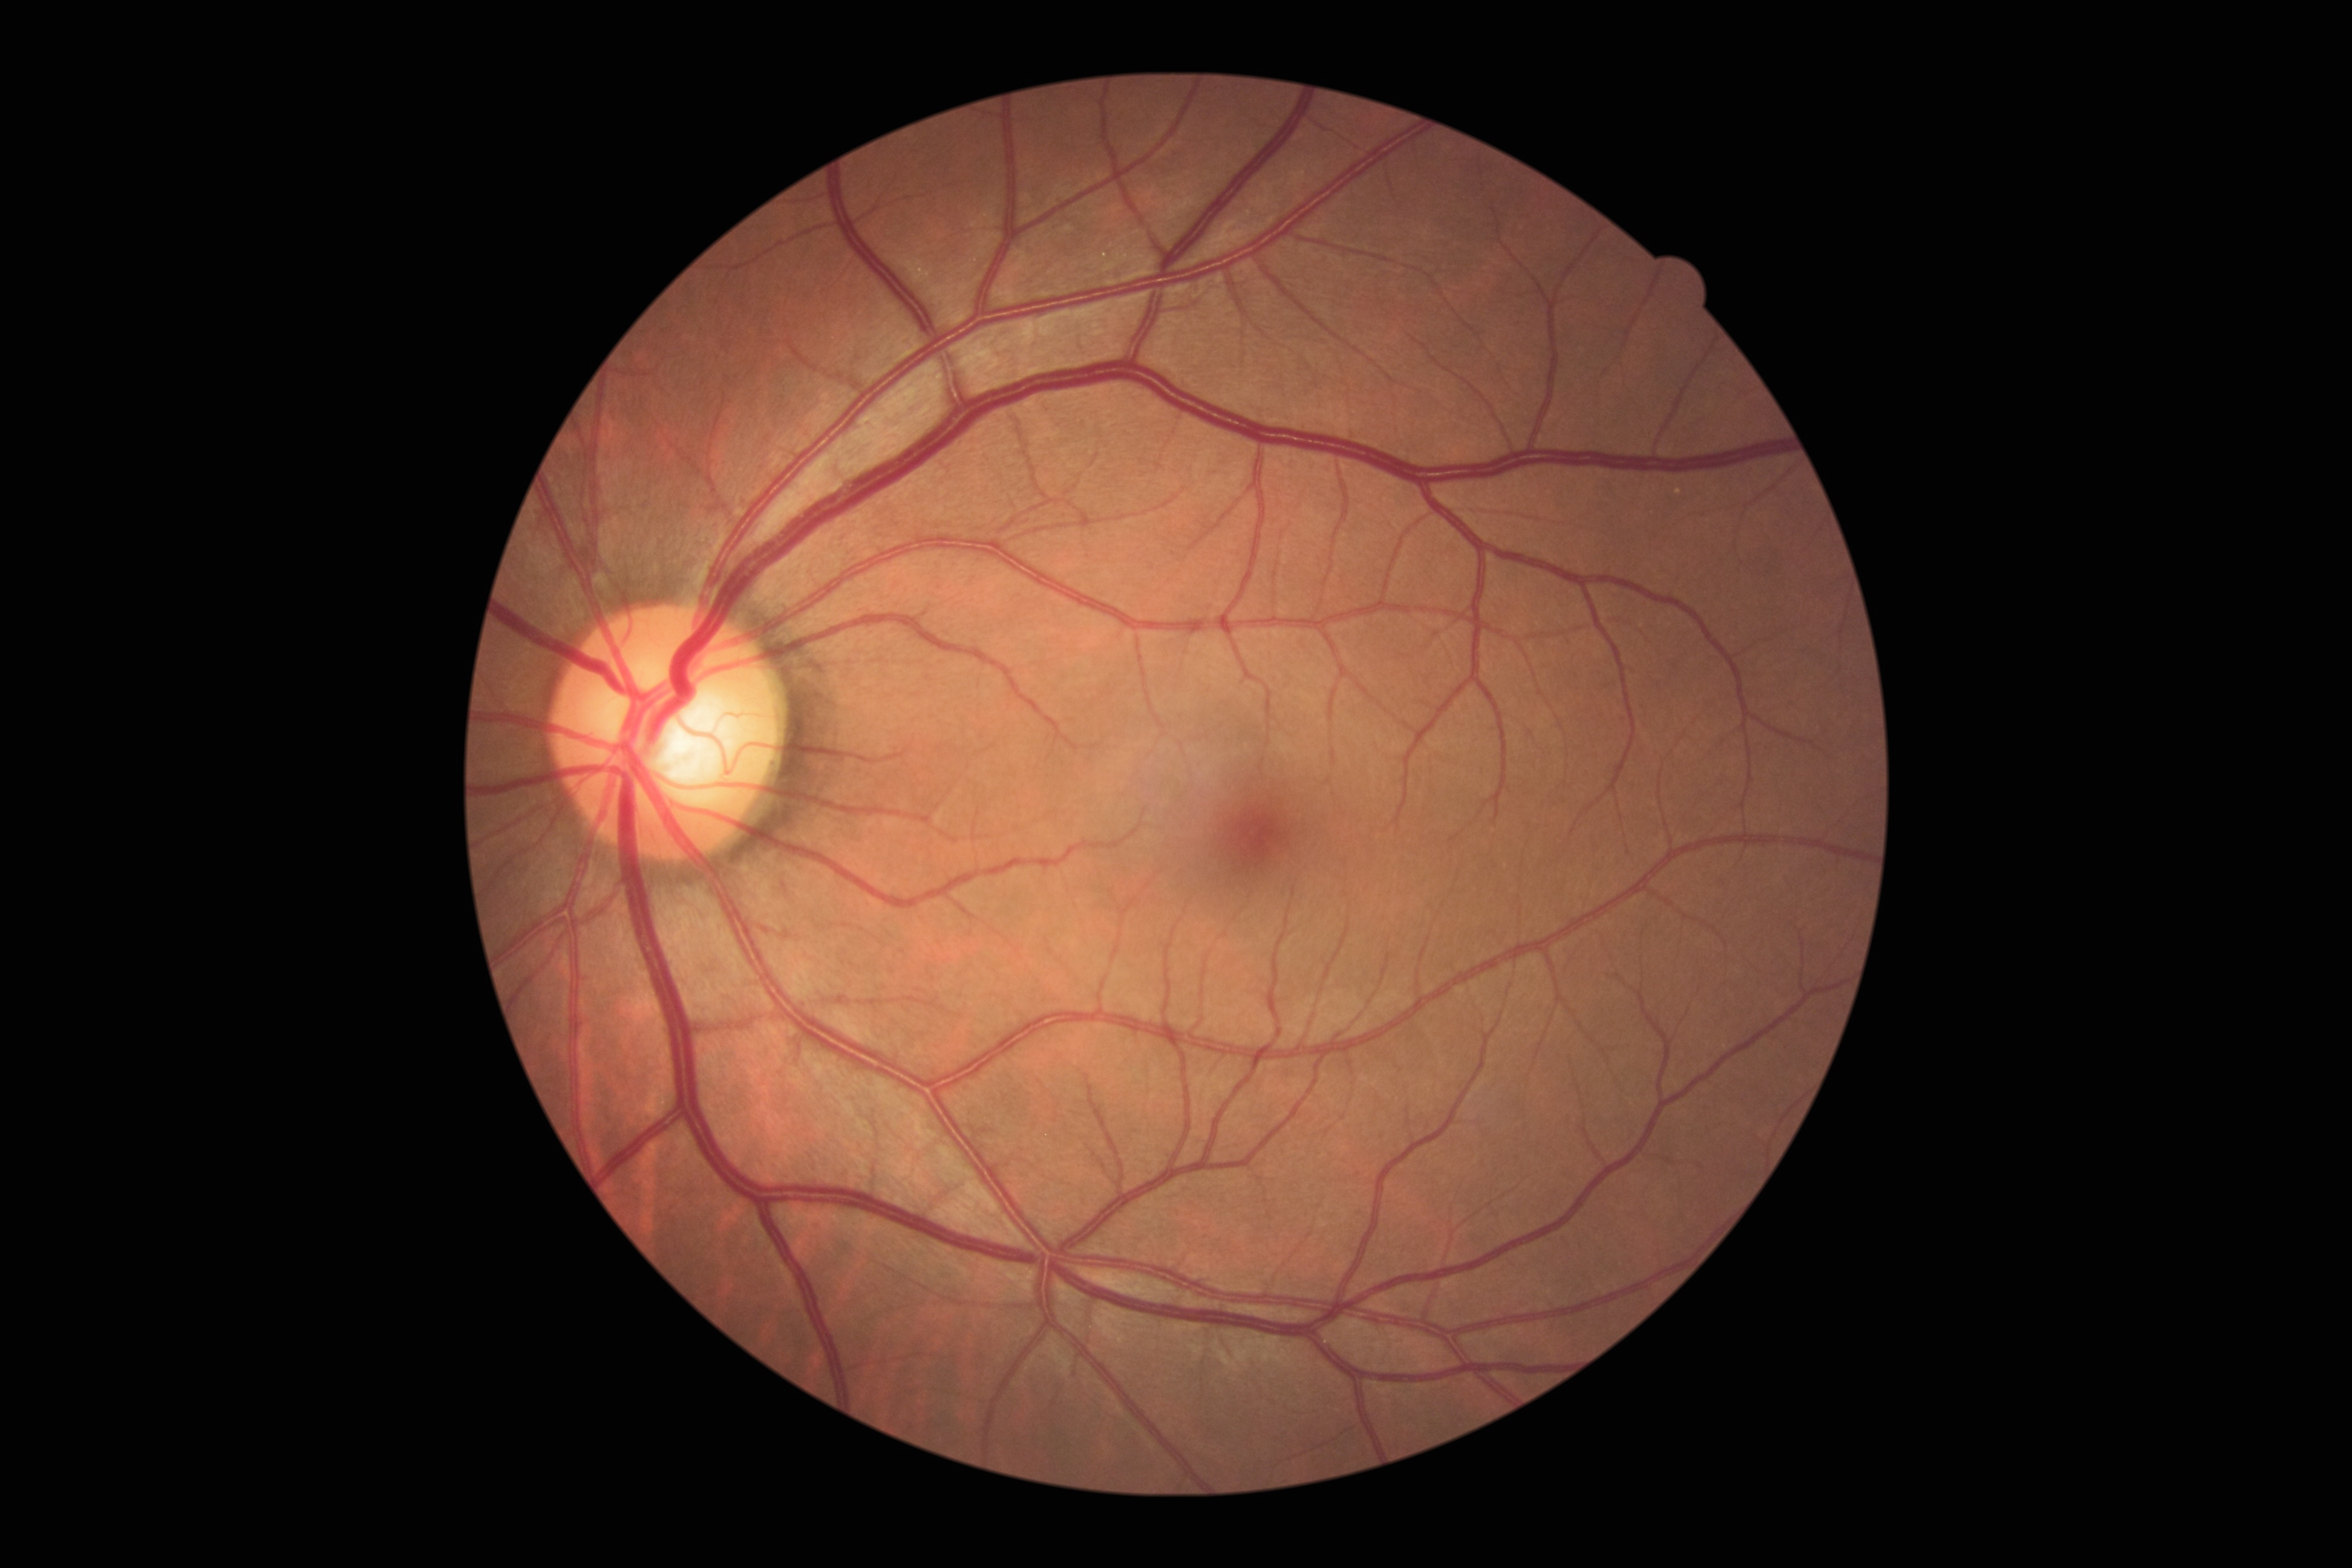 Diabetic retinopathy (DR): 0. No DR findings.